2102 x 1736 pixels: 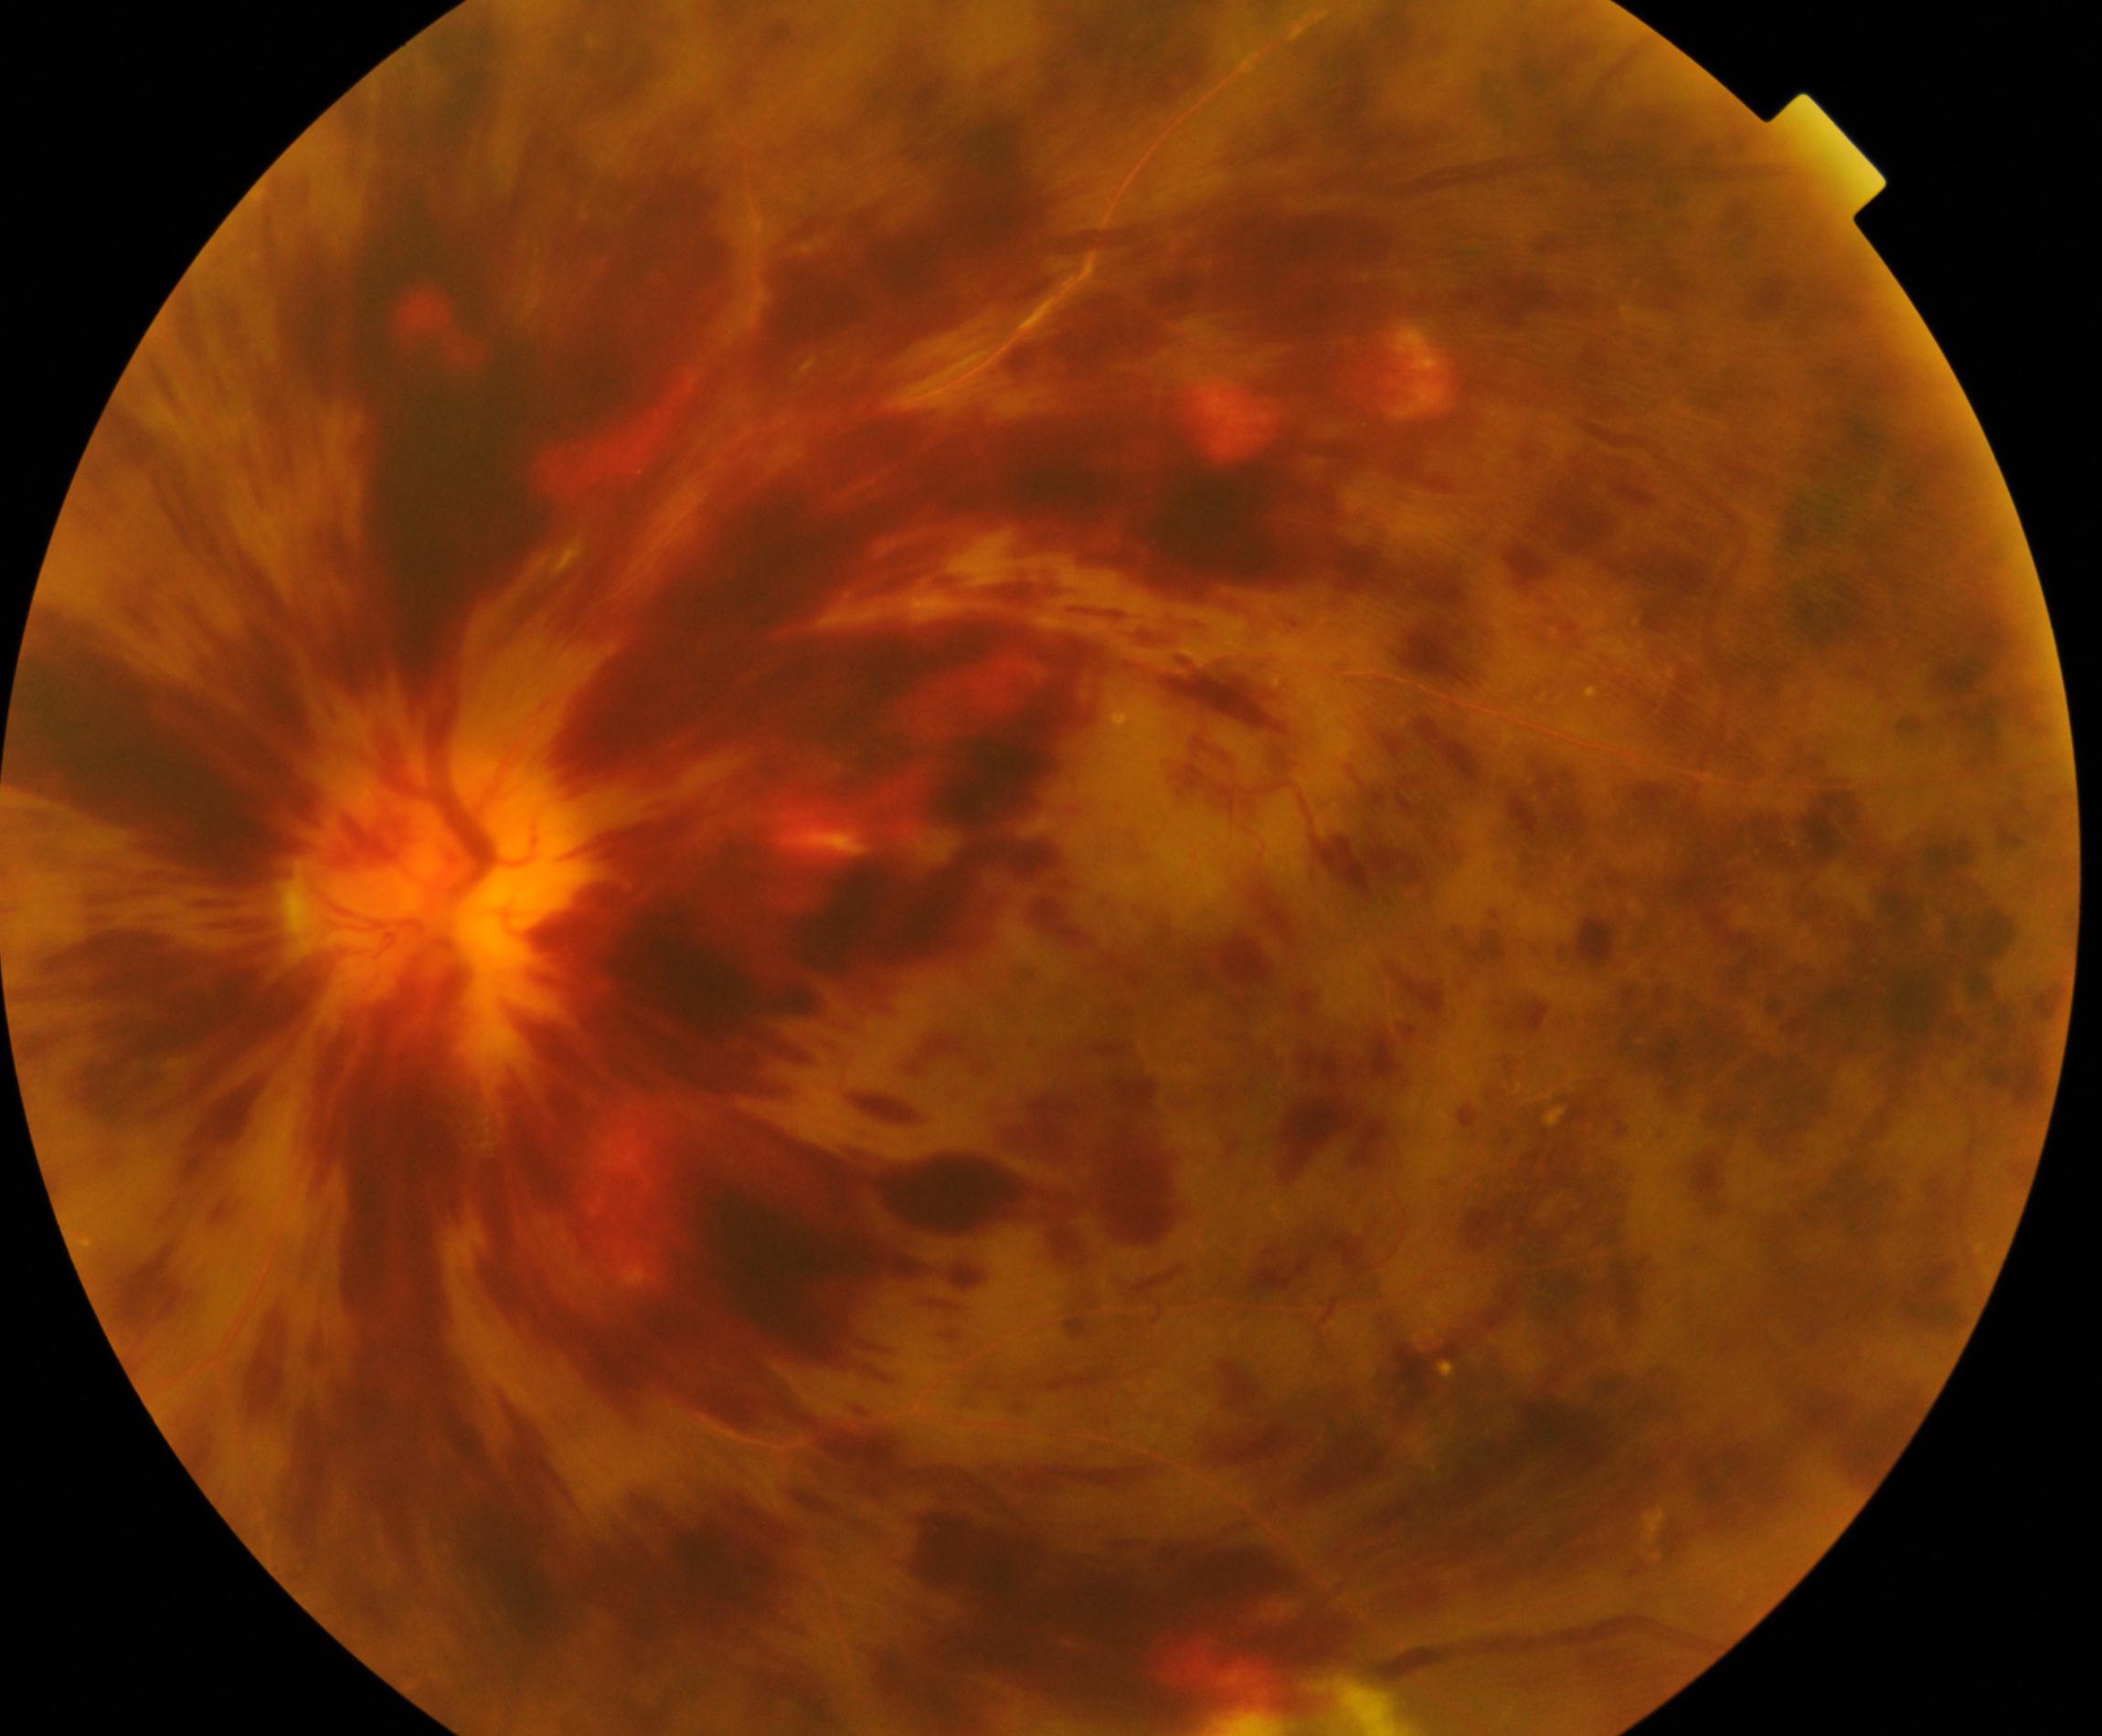
Findings: central retinal vein occlusion.